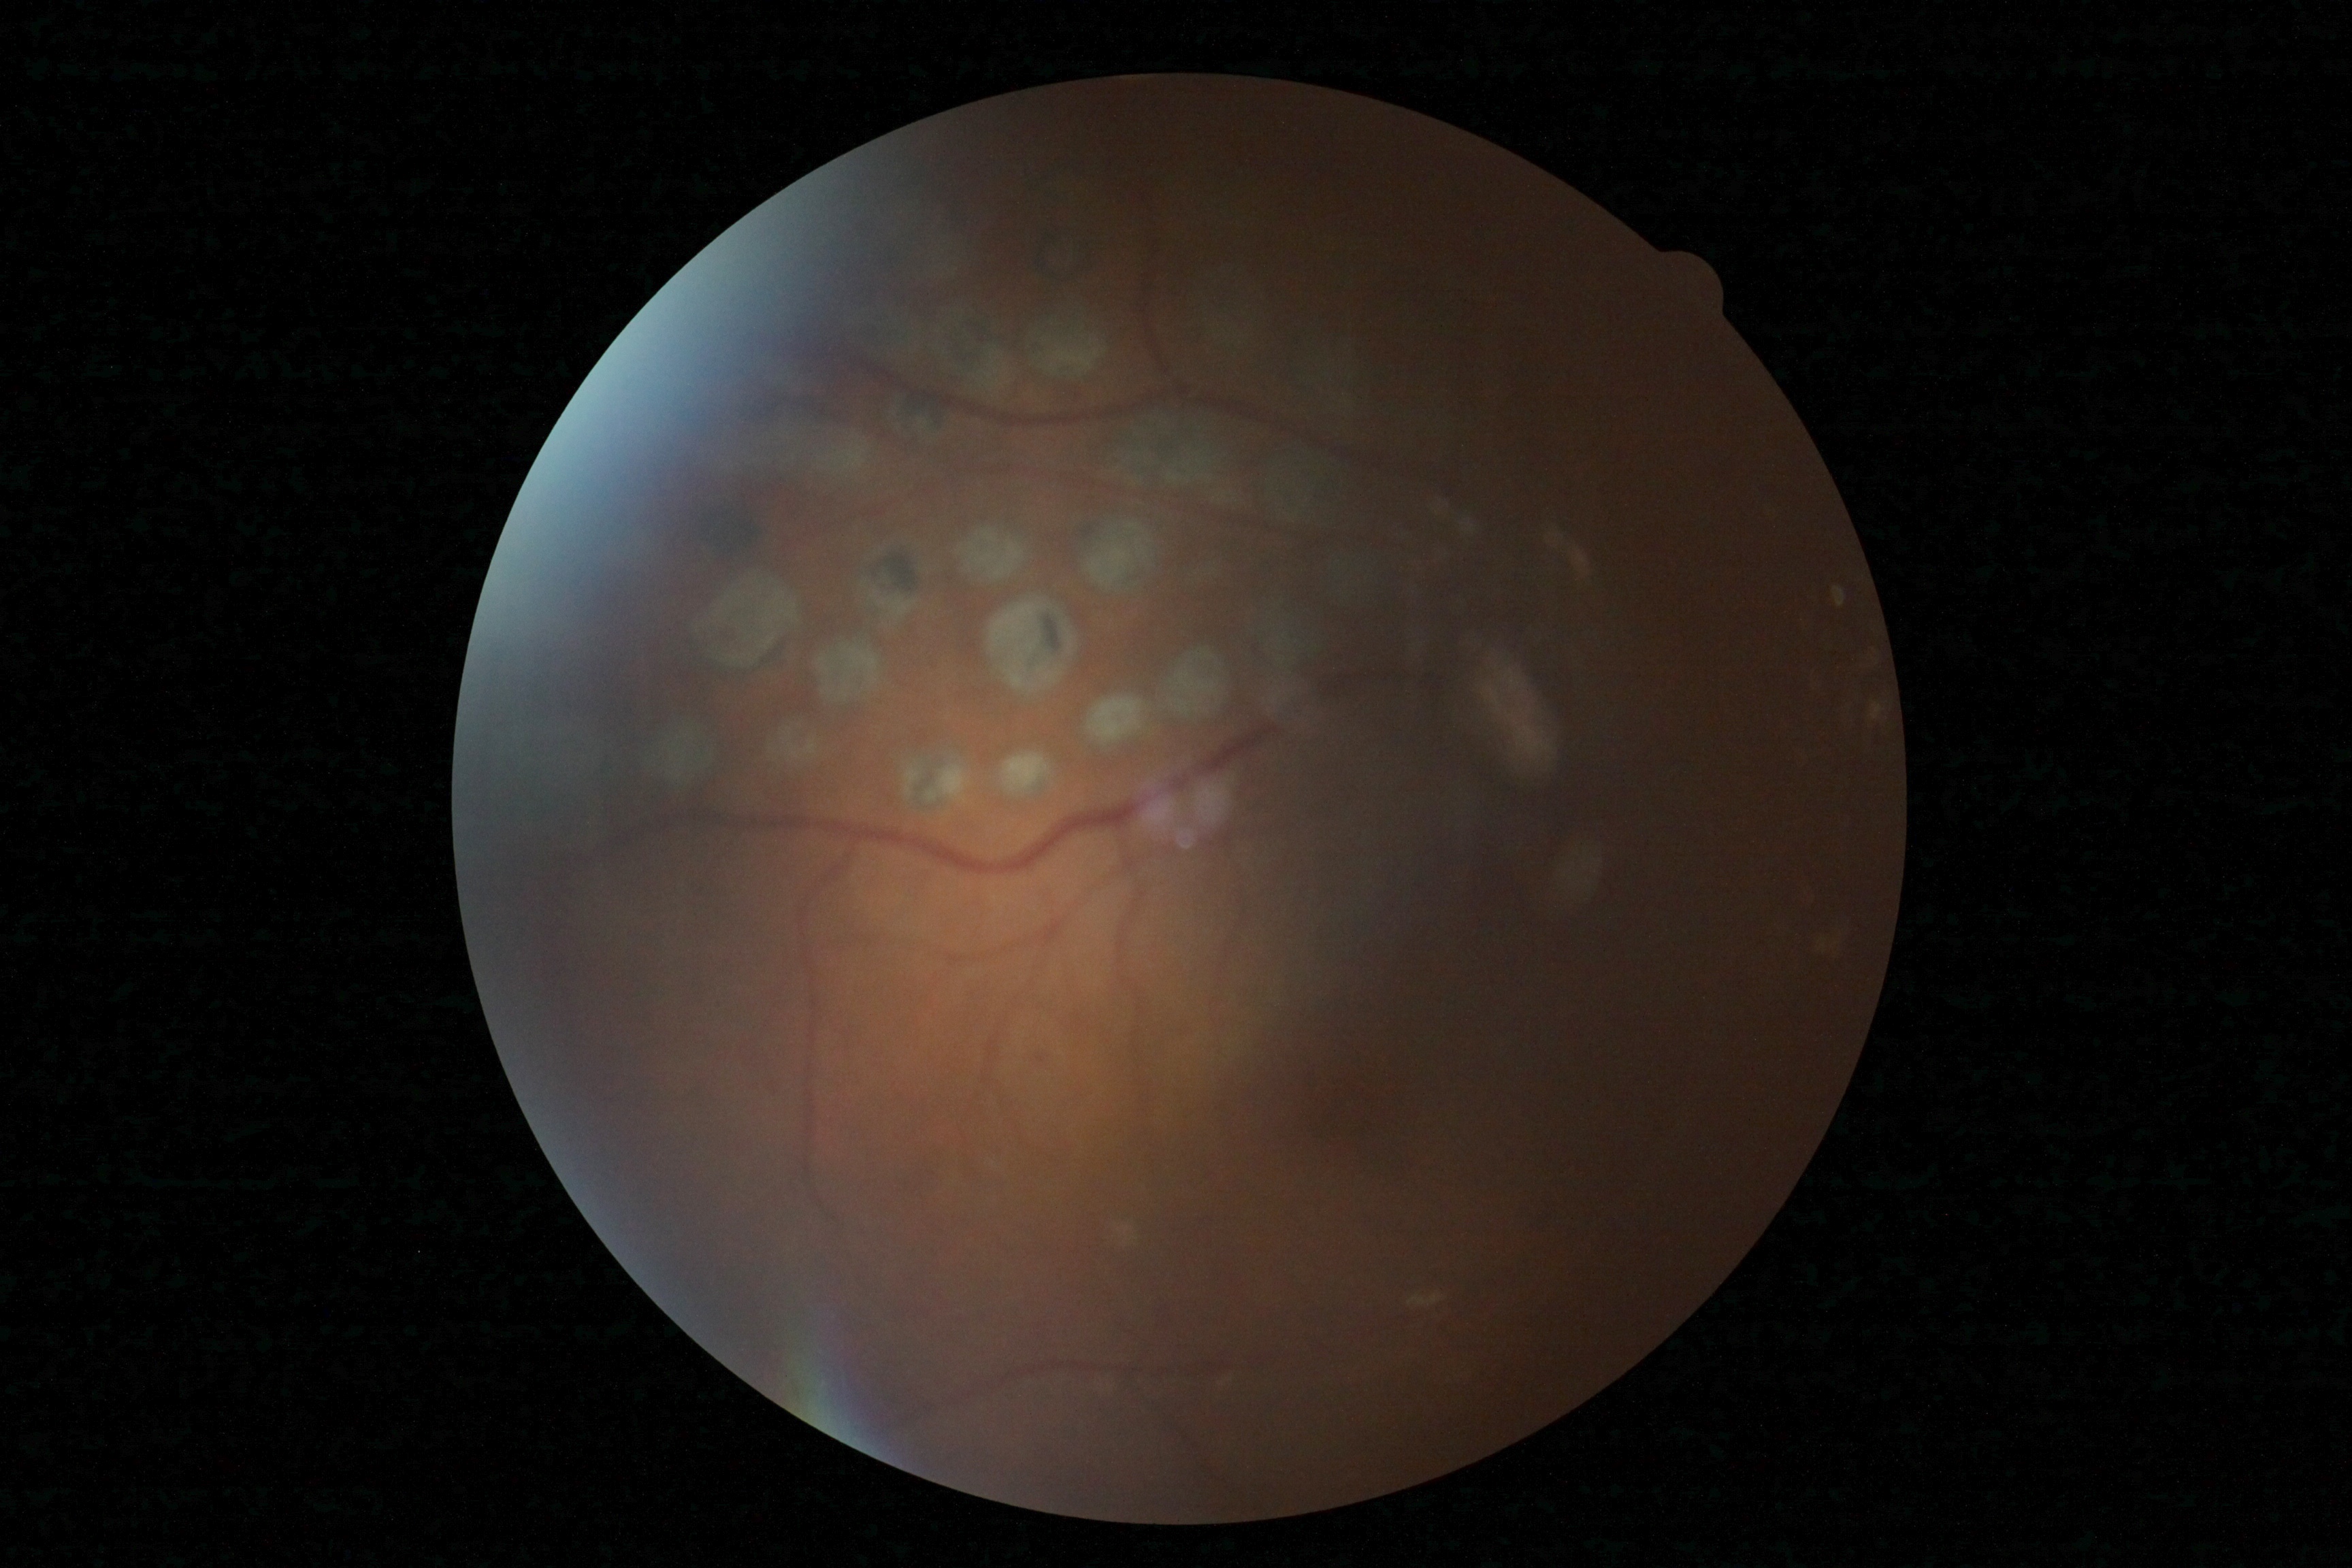 Retinopathy: grade 2 (moderate NPDR) — more than just microaneurysms but less than severe NPDR.